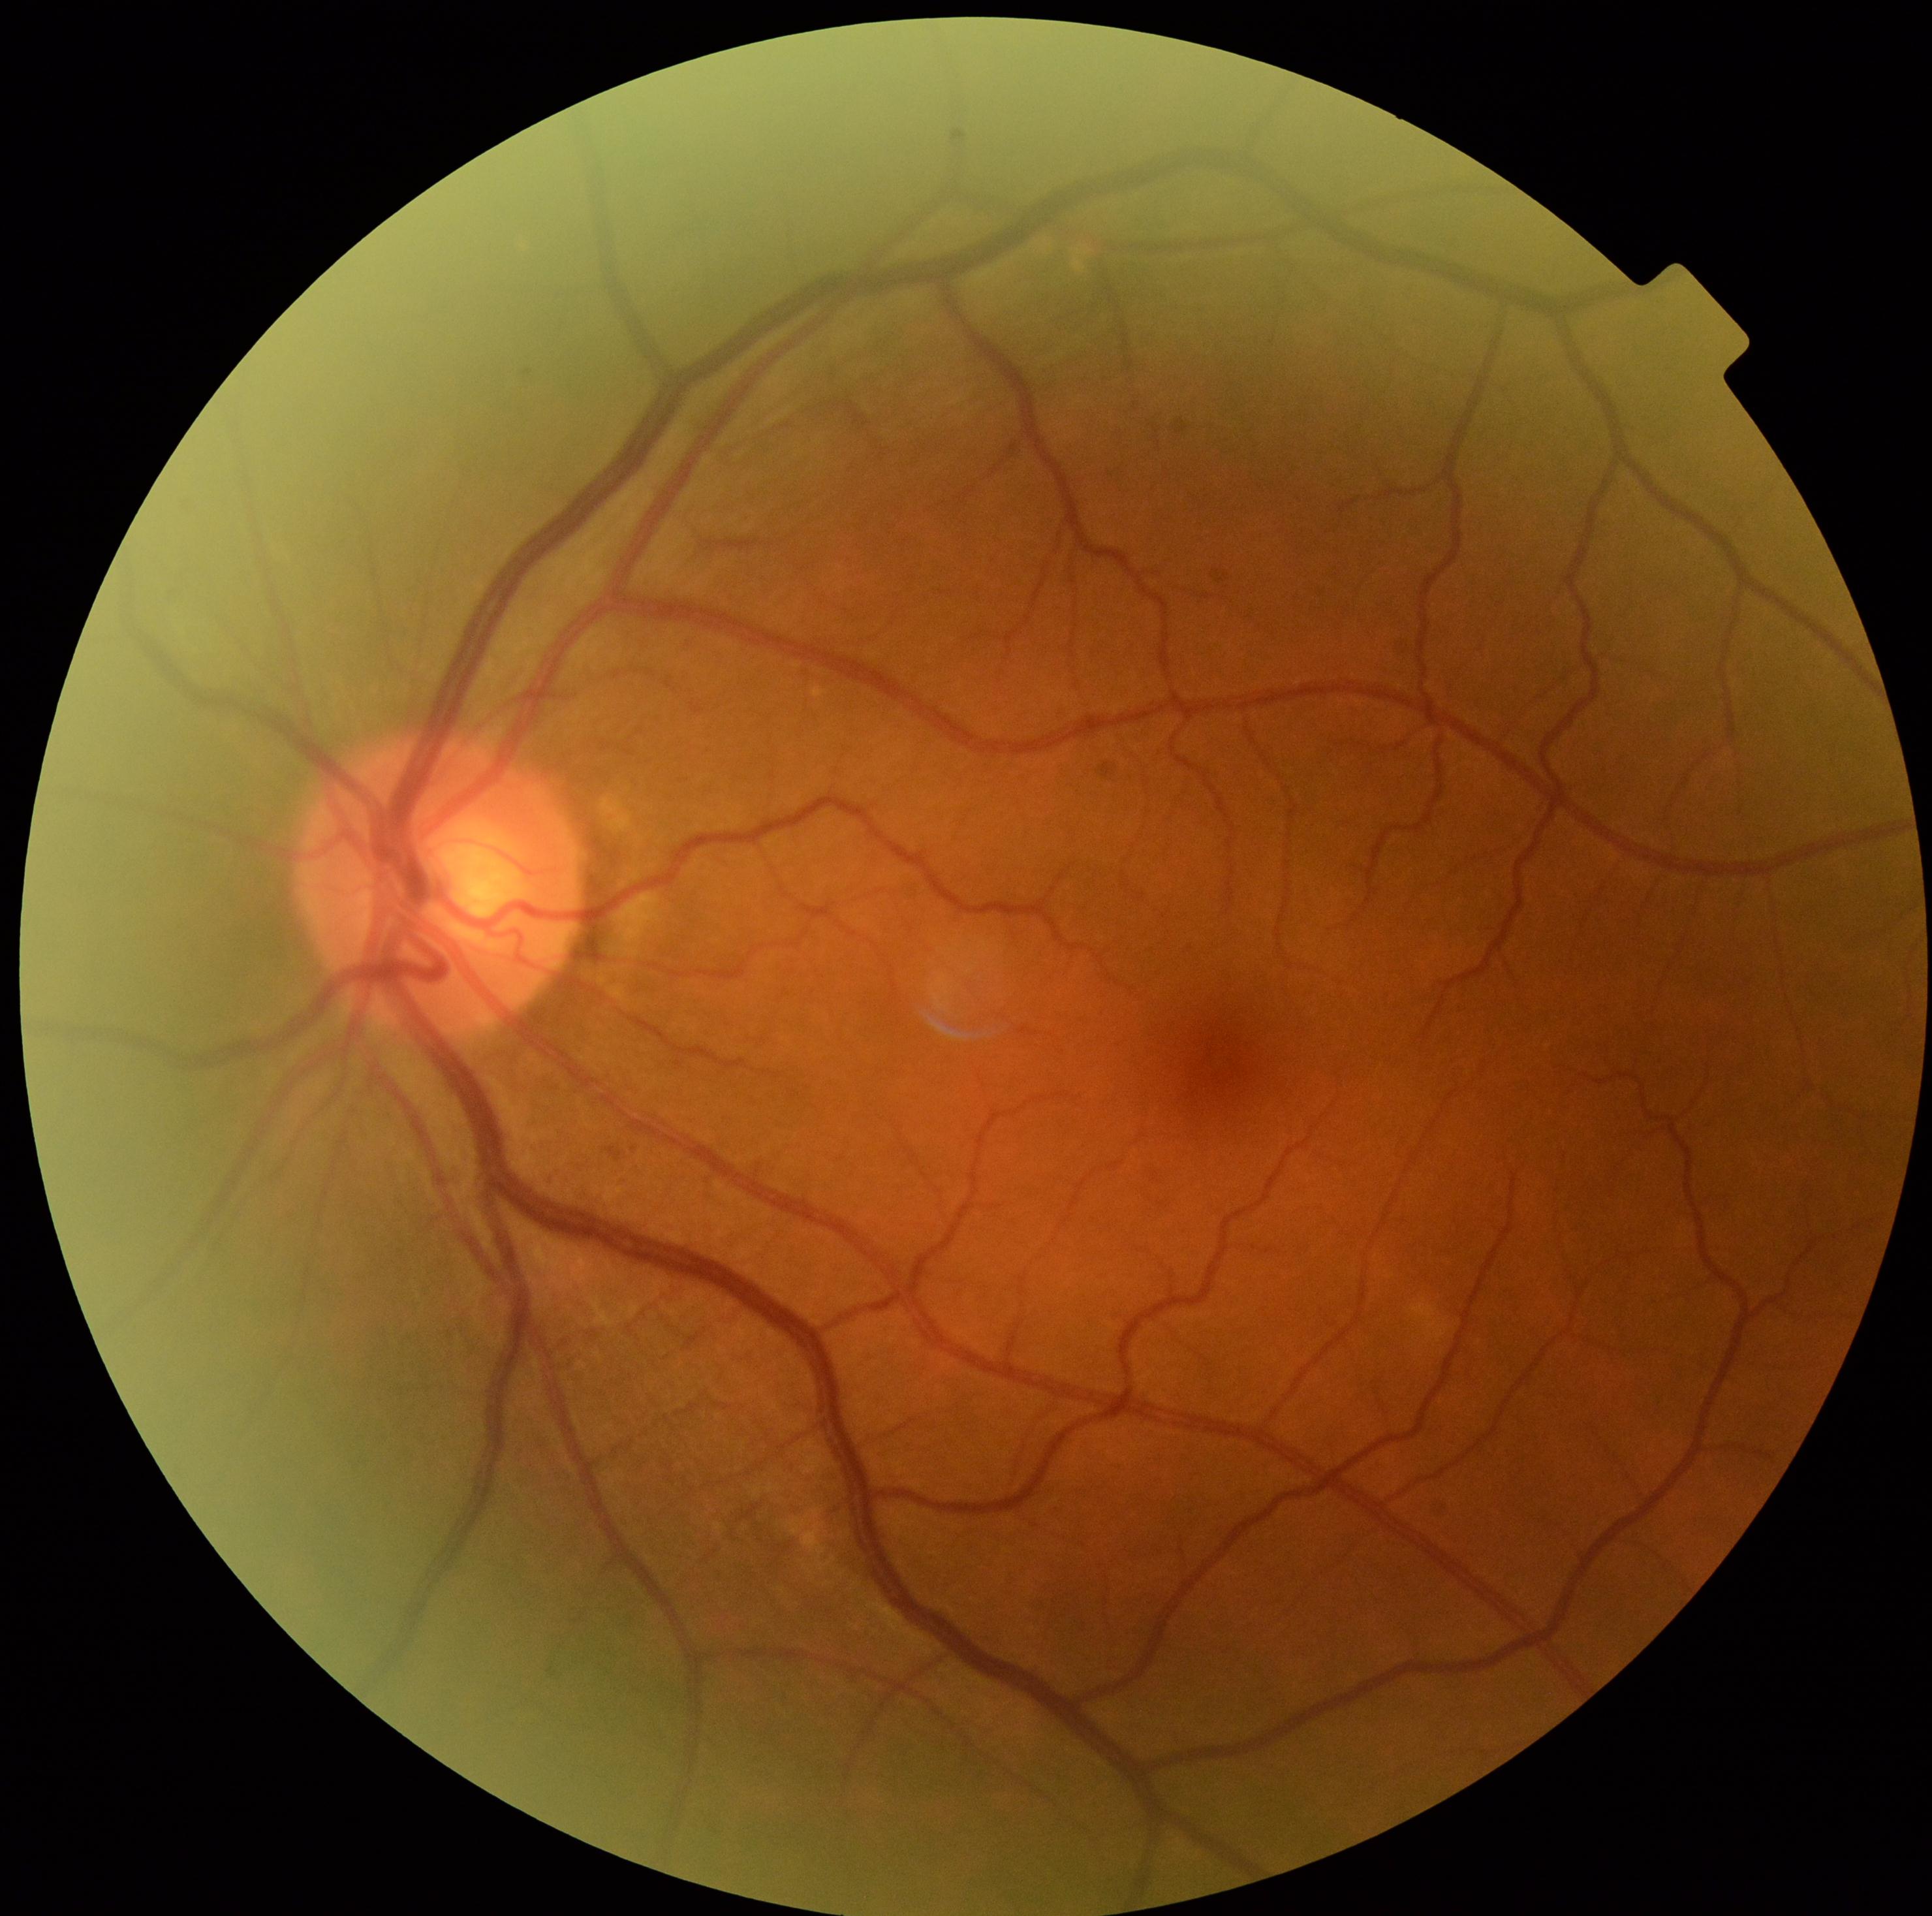
Retinopathy grade: 1 (mild NPDR).